Optic nerve head photograph. Topcon TRC retinal camera, IMAGEnet capture system. Dilated pupil
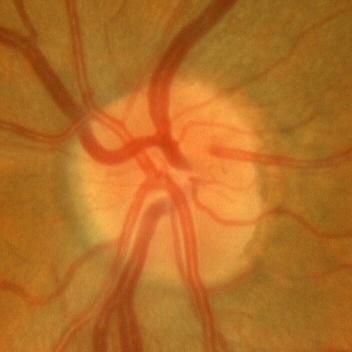 No glaucoma.